CFP
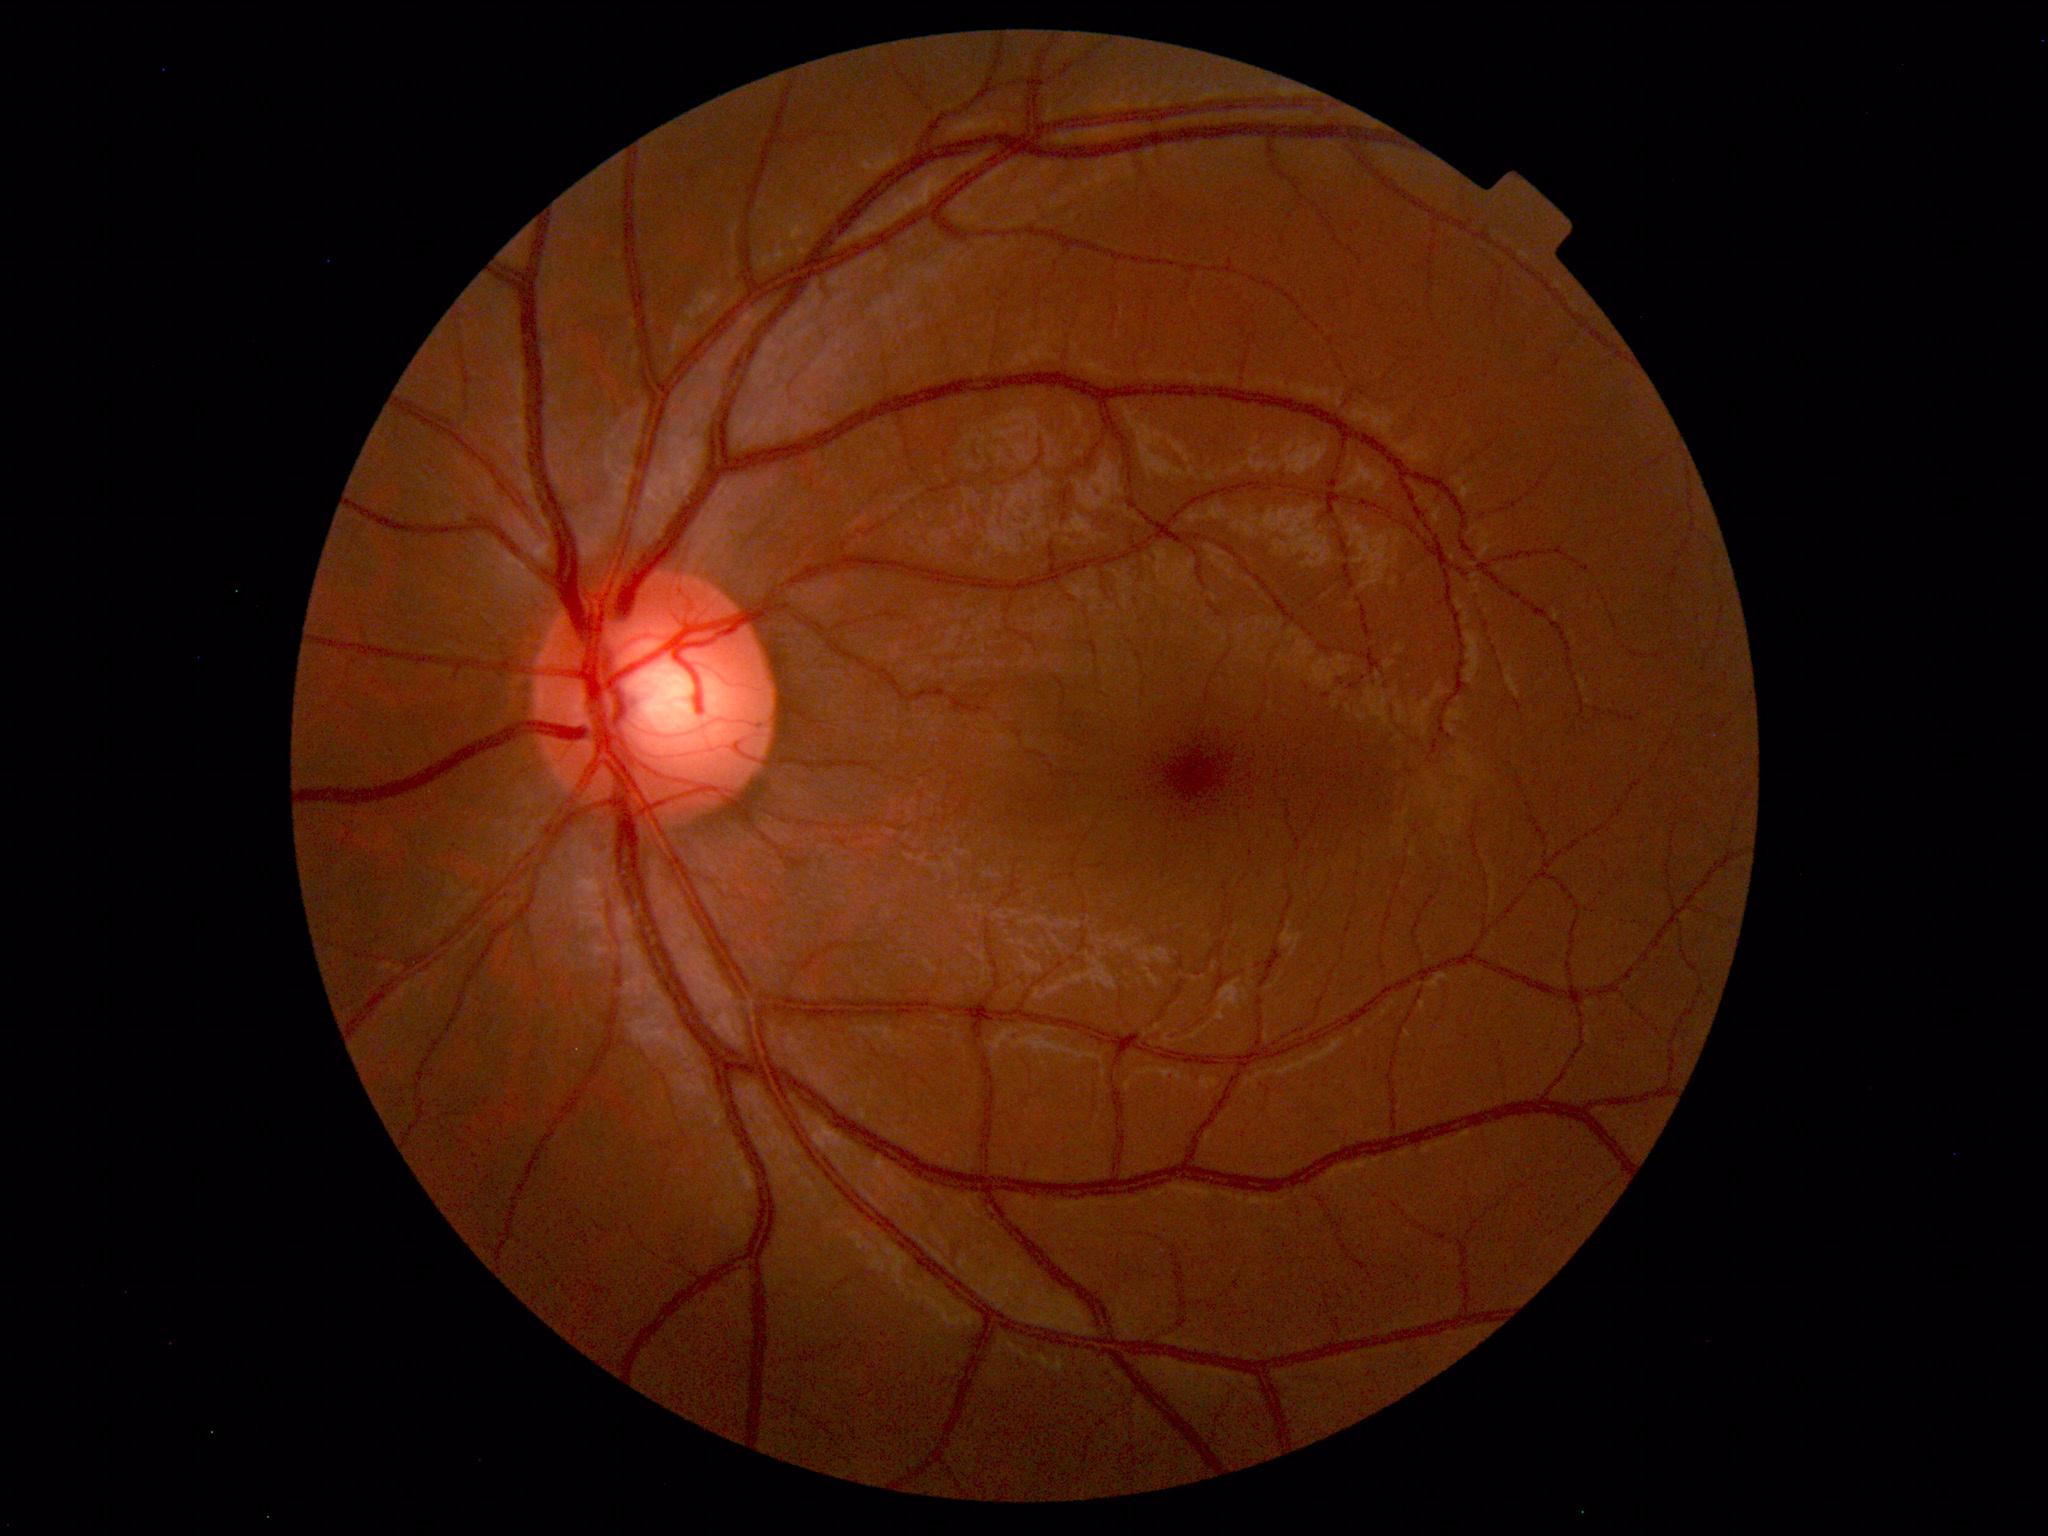 Impression: within normal limits.